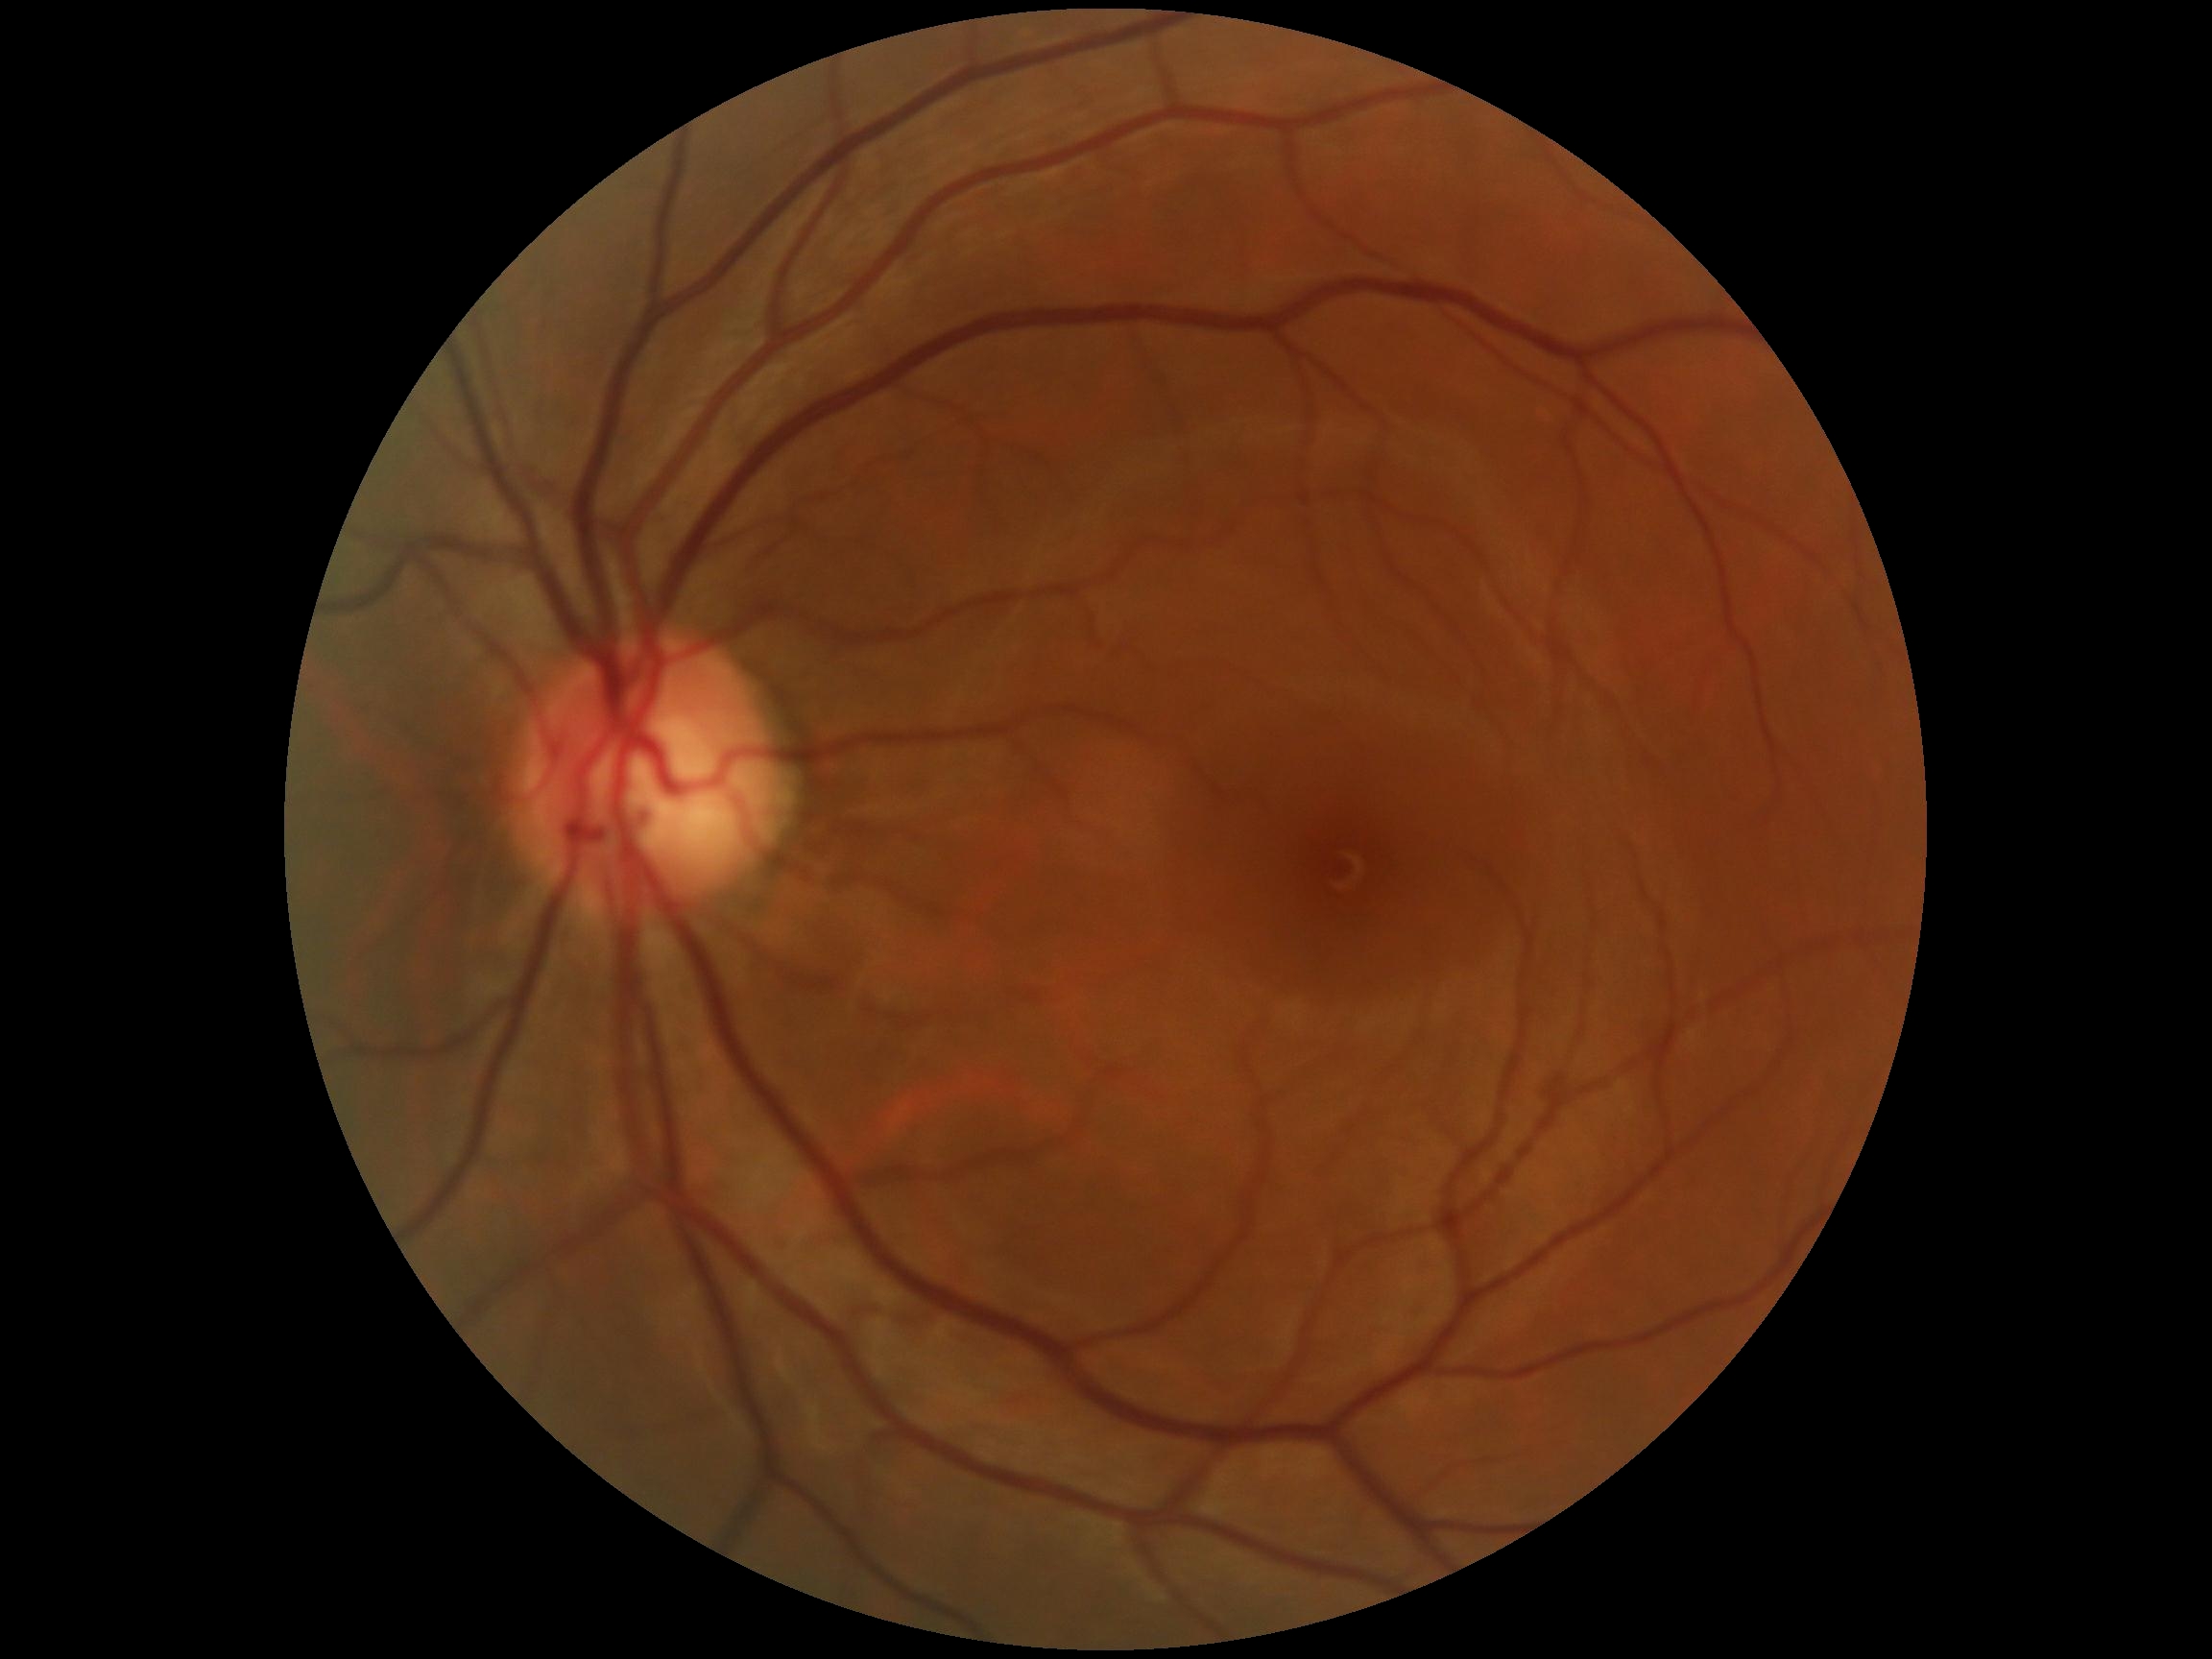 diabetic retinopathy (DR) = grade 0.